2352 x 1568 pixels. 45° FOV
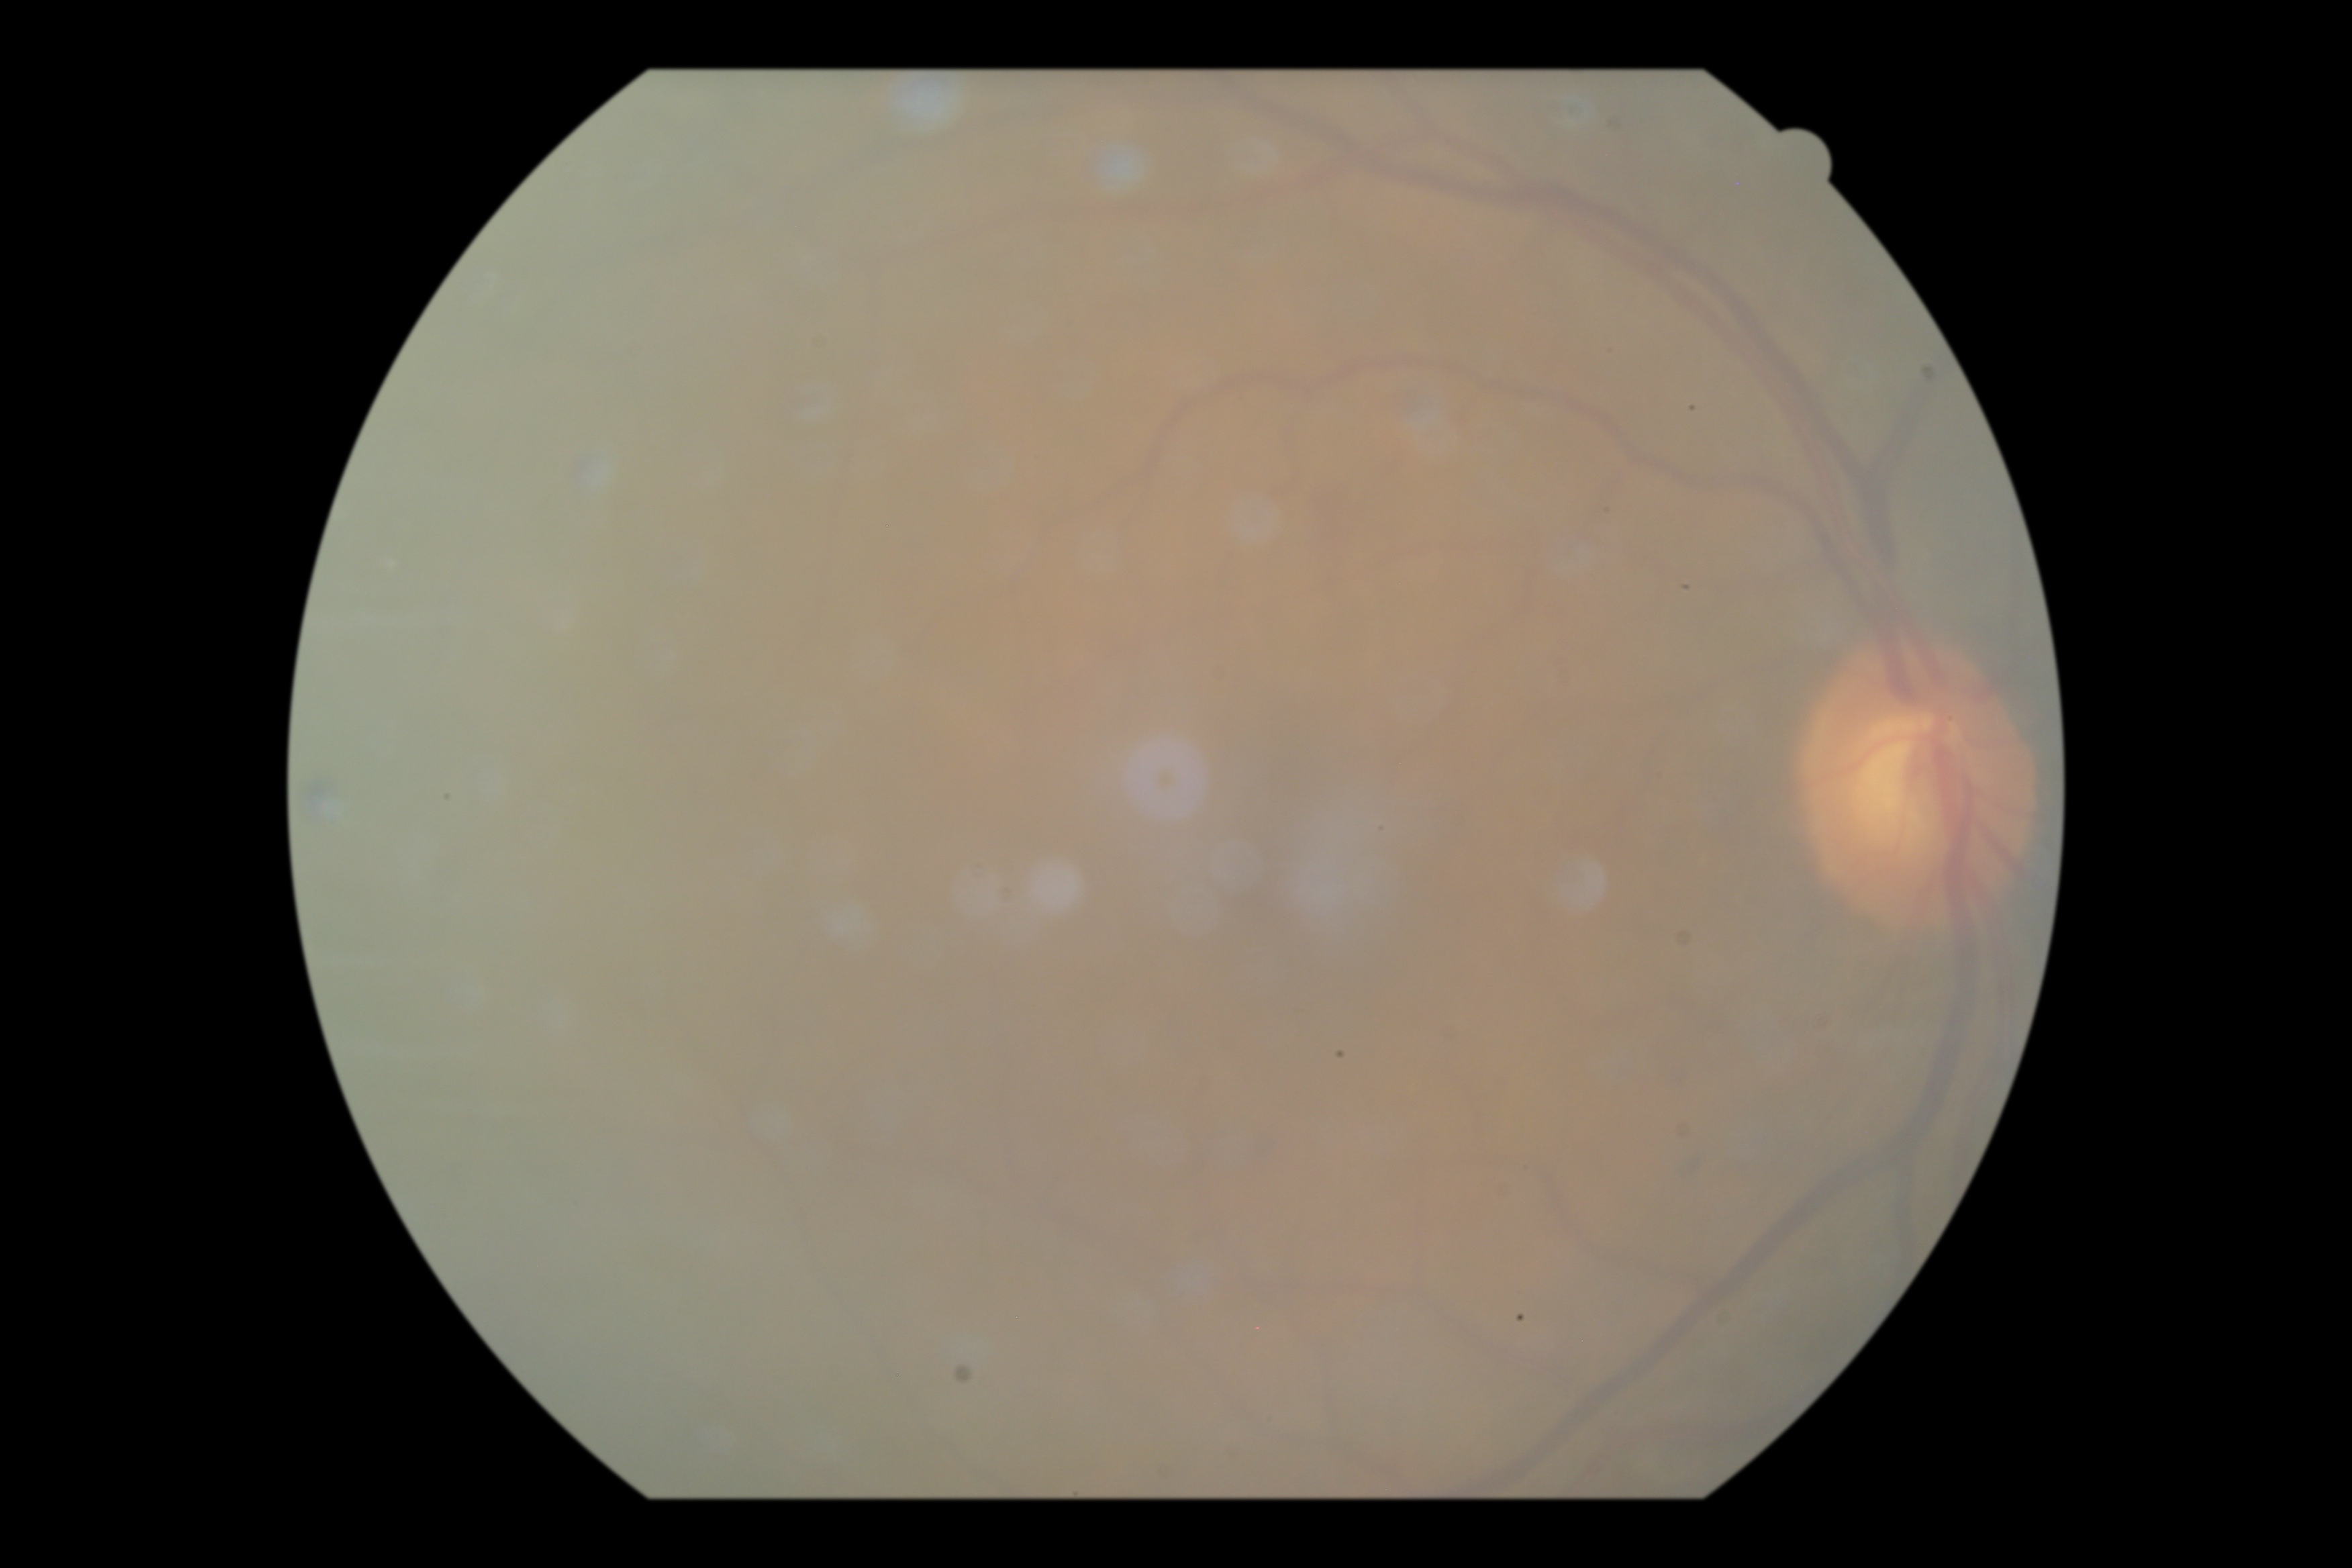
DR: no apparent diabetic retinopathy (grade 0).